45° field of view:
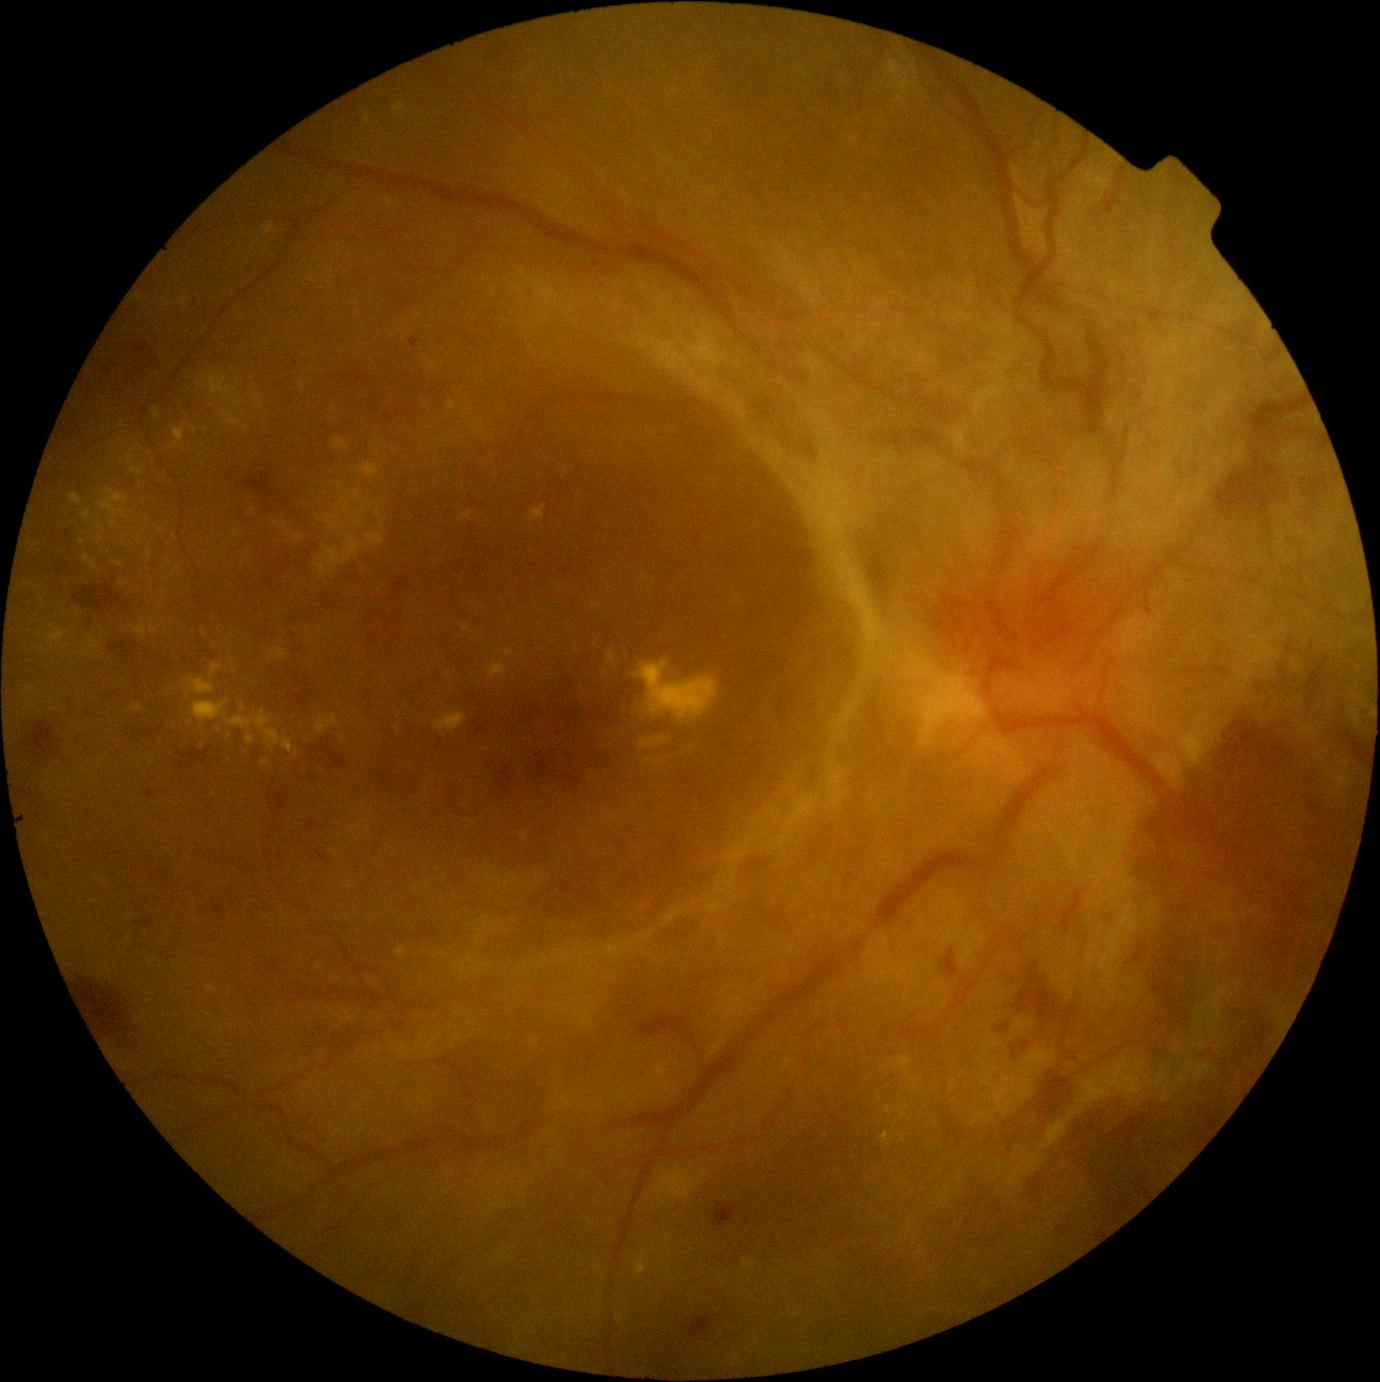
DR class = proliferative diabetic retinopathy | DR = grade 4 (PDR) — neovascularization and/or vitreous/pre-retinal hemorrhage.